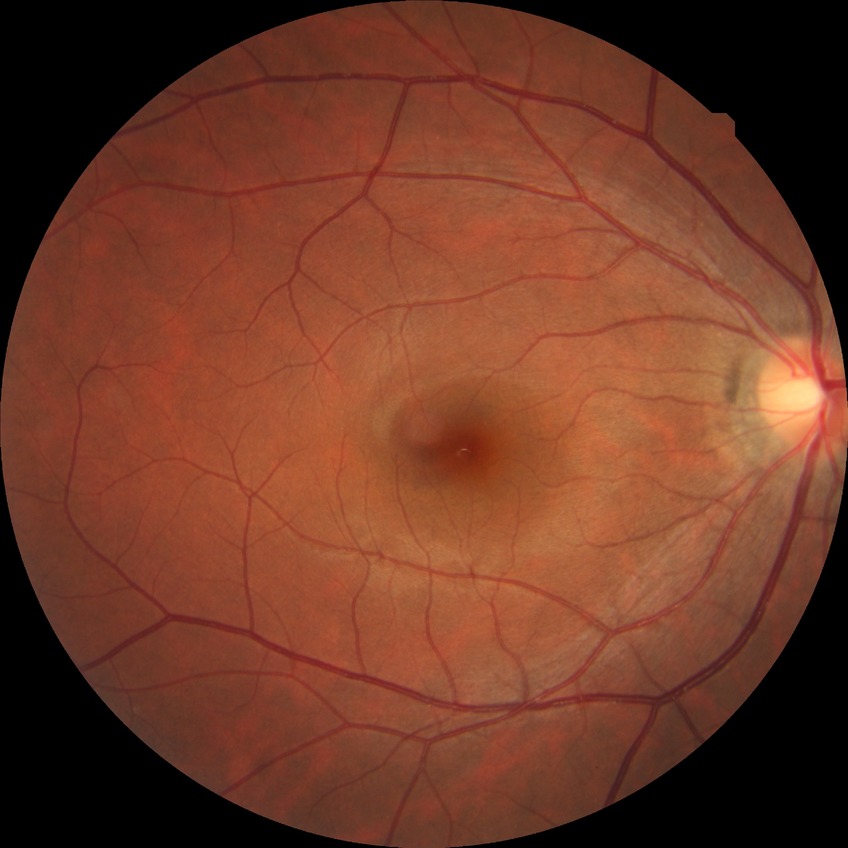 Diabetic retinopathy (DR): NDR (no diabetic retinopathy).